Wide-field fundus photograph from neonatal ROP screening · 130° field of view (Natus RetCam Envision) · 1440 by 1080 pixels.
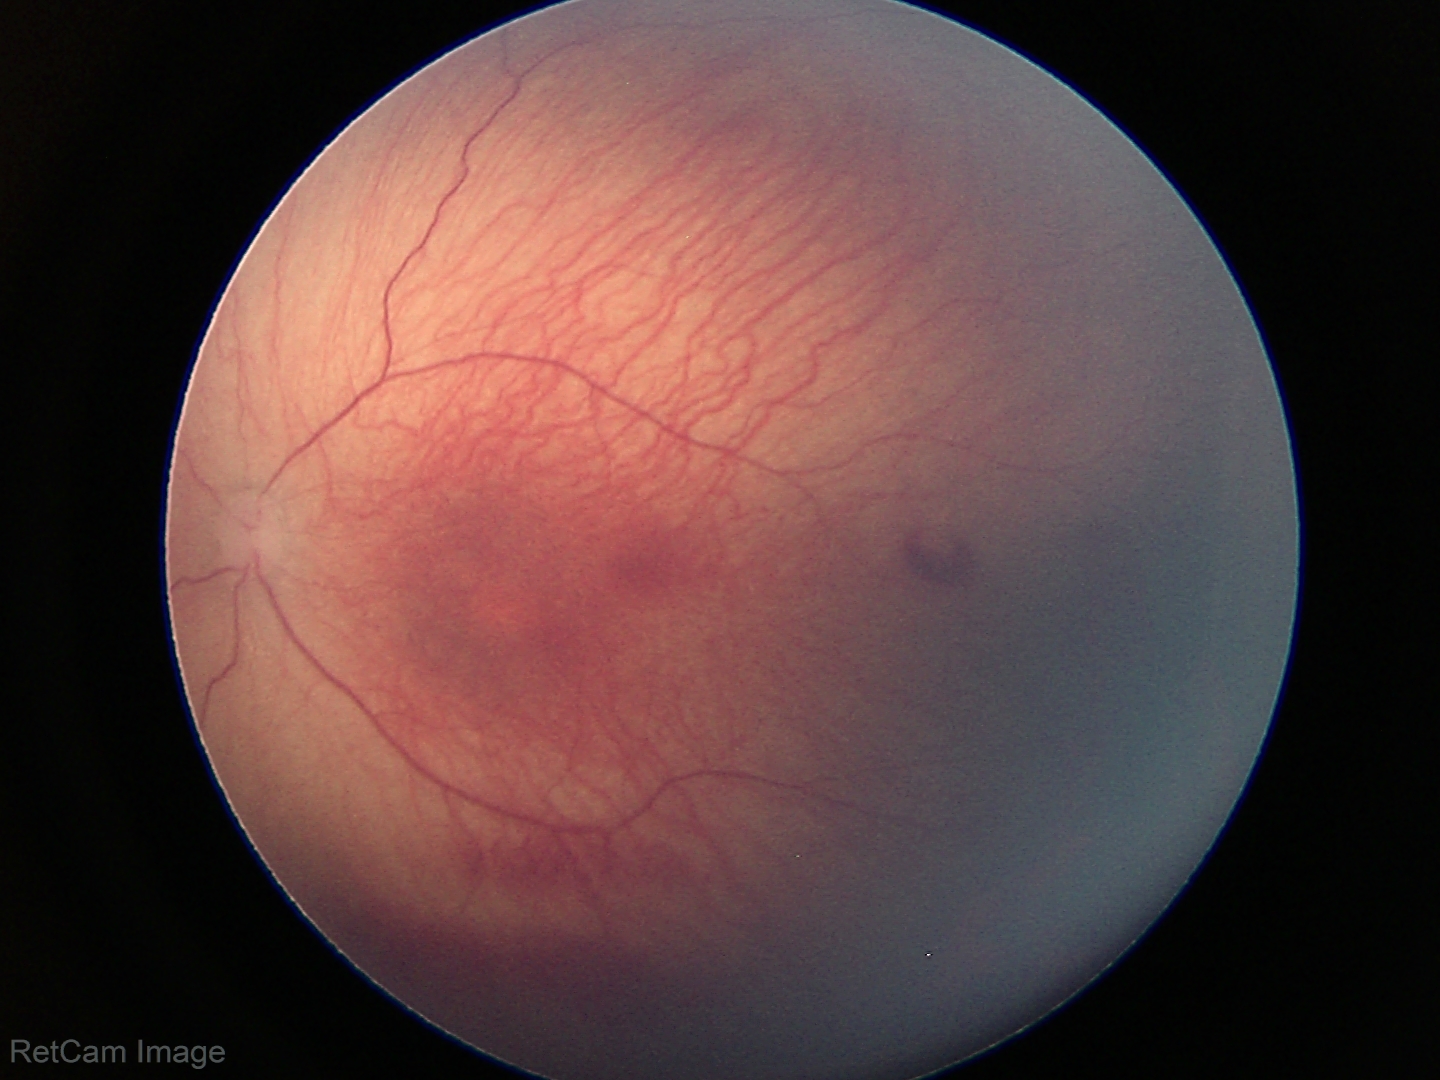 Screening diagnosis = retinopathy of prematurity (ROP) stage 1 — demarcation line between vascular and avascular retina.